Posterior pole color fundus photograph — 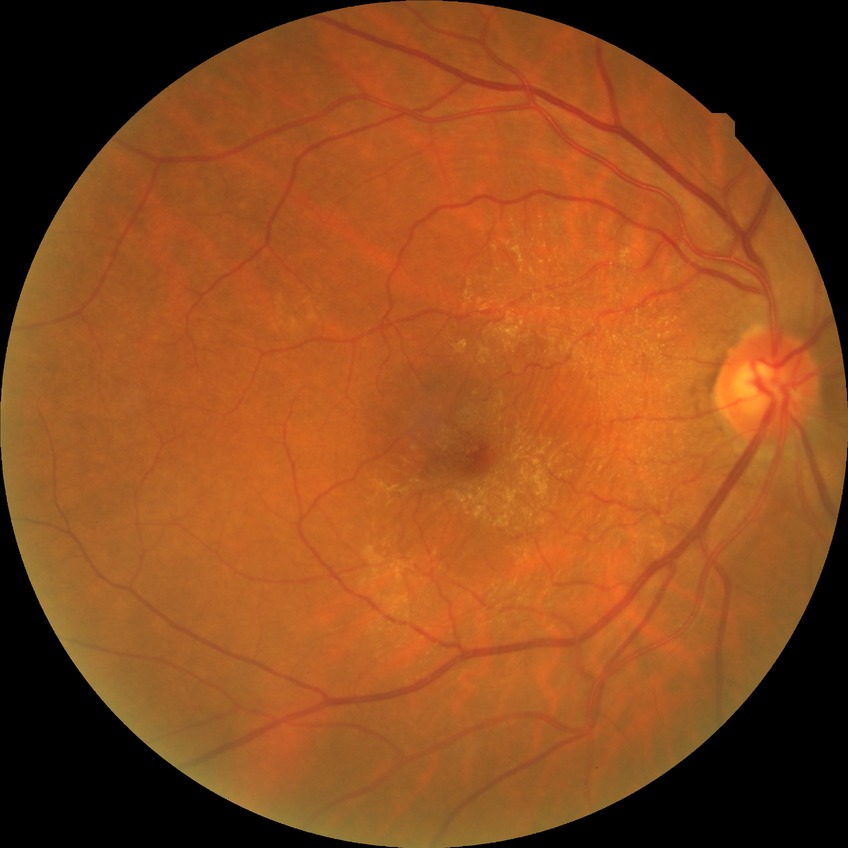

diabetic retinopathy stage: no diabetic retinopathy.